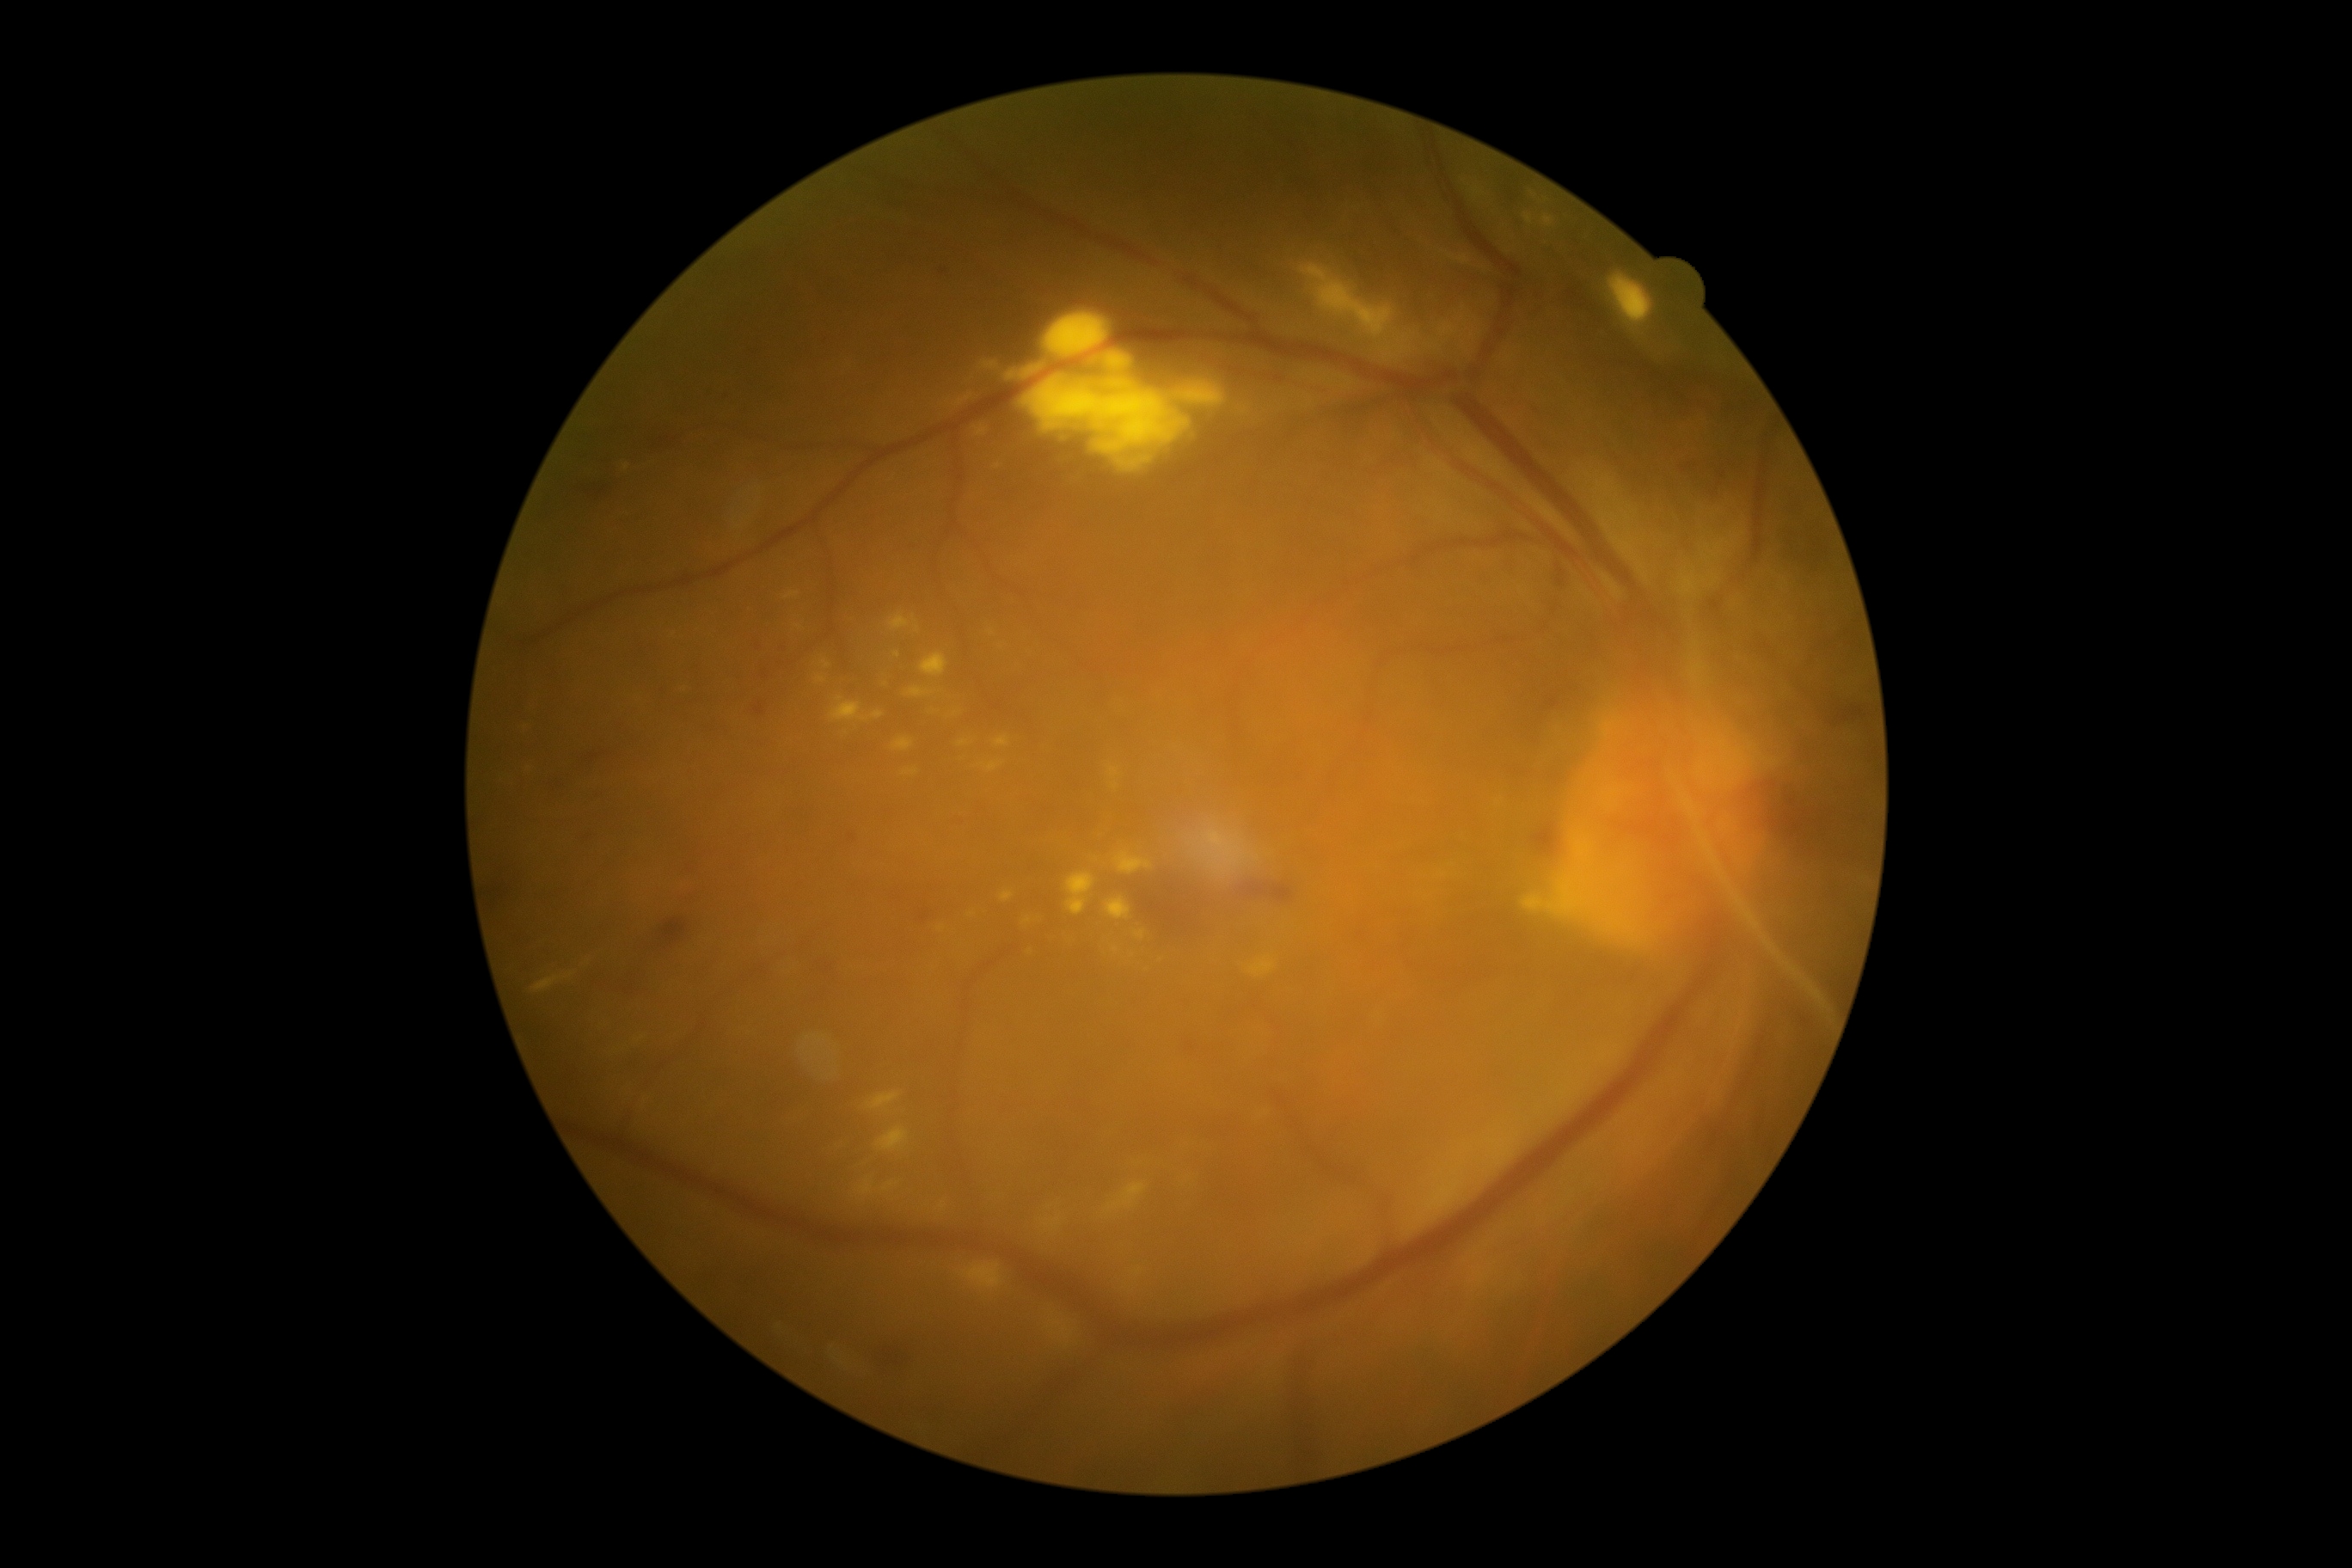 Diabetic retinopathy (DR) is grade 4 (PDR)
Selected lesions:
* hard exudates (EXs) (partial): bbox(1010, 371, 1022, 379), bbox(953, 393, 974, 408), bbox(1543, 216, 1553, 228), bbox(1022, 917, 1032, 926), bbox(940, 1203, 948, 1211), bbox(532, 972, 575, 995), bbox(1299, 266, 1395, 340), bbox(979, 763, 1003, 773), bbox(962, 1263, 1005, 1290), bbox(921, 652, 950, 677), bbox(867, 1093, 900, 1110), bbox(974, 426, 989, 438), bbox(1256, 1110, 1266, 1117), bbox(783, 592, 800, 601)
* Small EXs approximately at (1030,952), (1060,435), (1133,464), (684,690)